45° FOV — 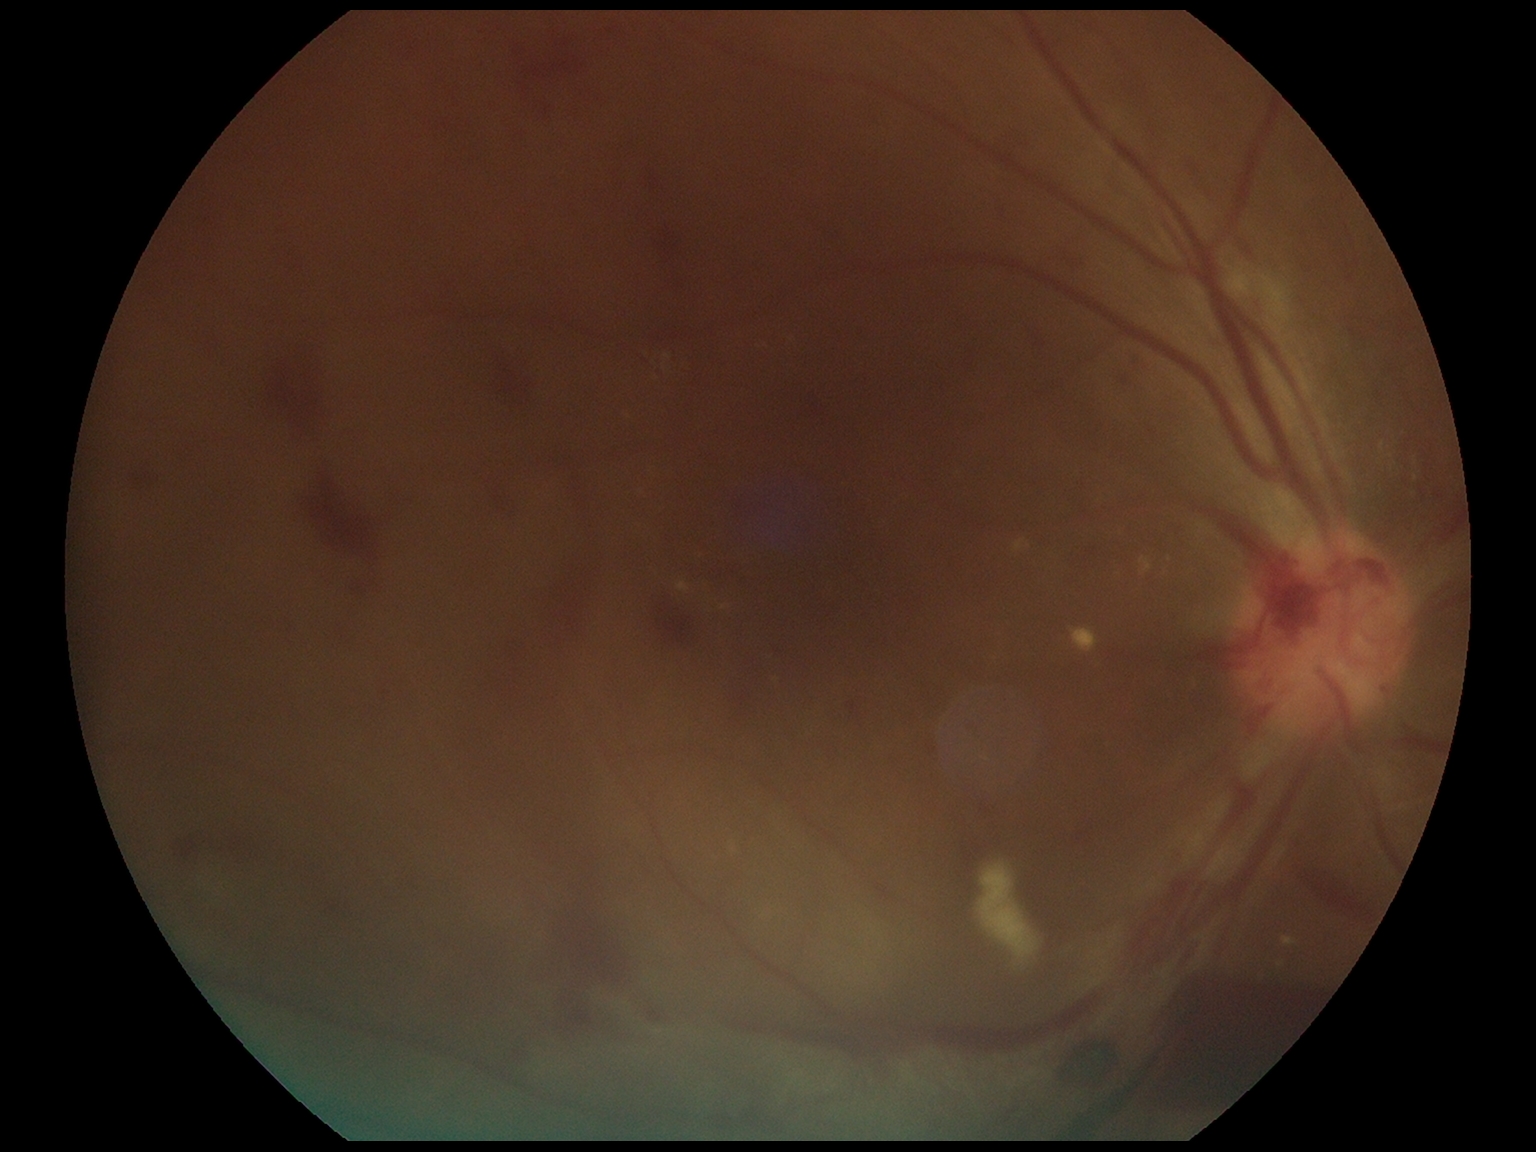 Disease class: proliferative diabetic retinopathy. Retinopathy grade: 4 (PDR) — neovascularization and/or vitreous/pre-retinal hemorrhage.